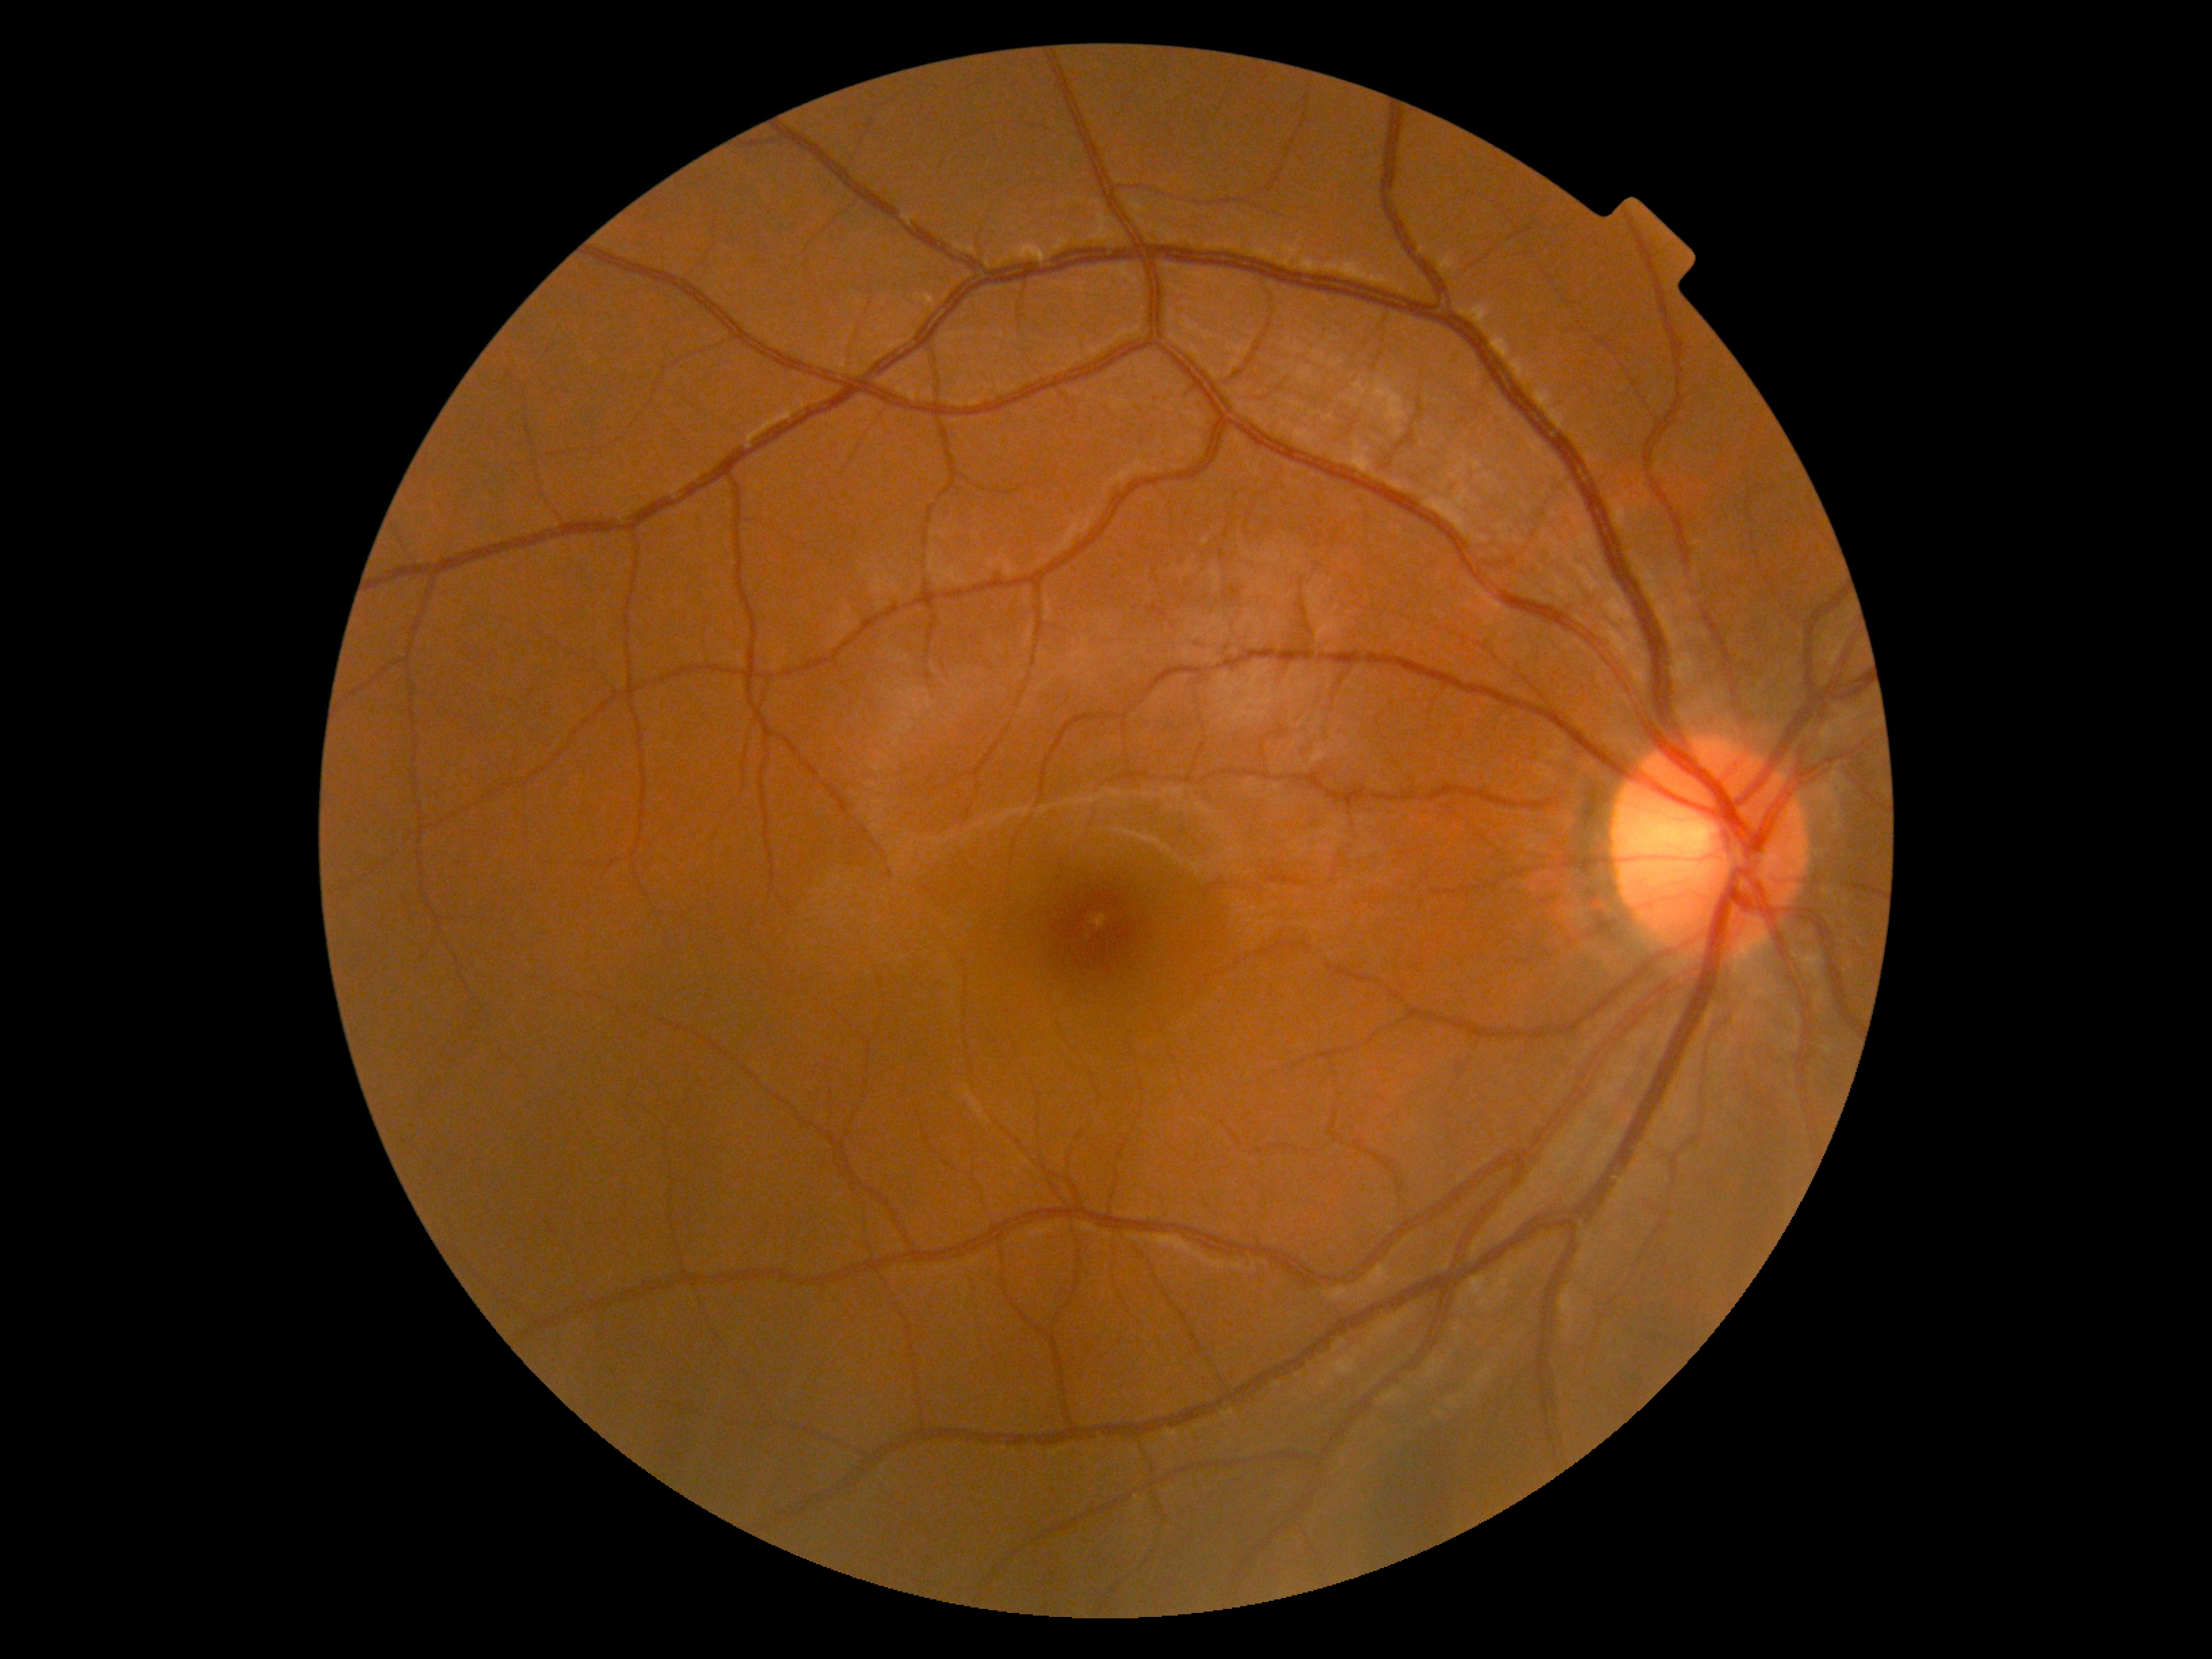 diabetic retinopathy (DR)=no apparent retinopathy (grade 0).